Image size 2352x1568:
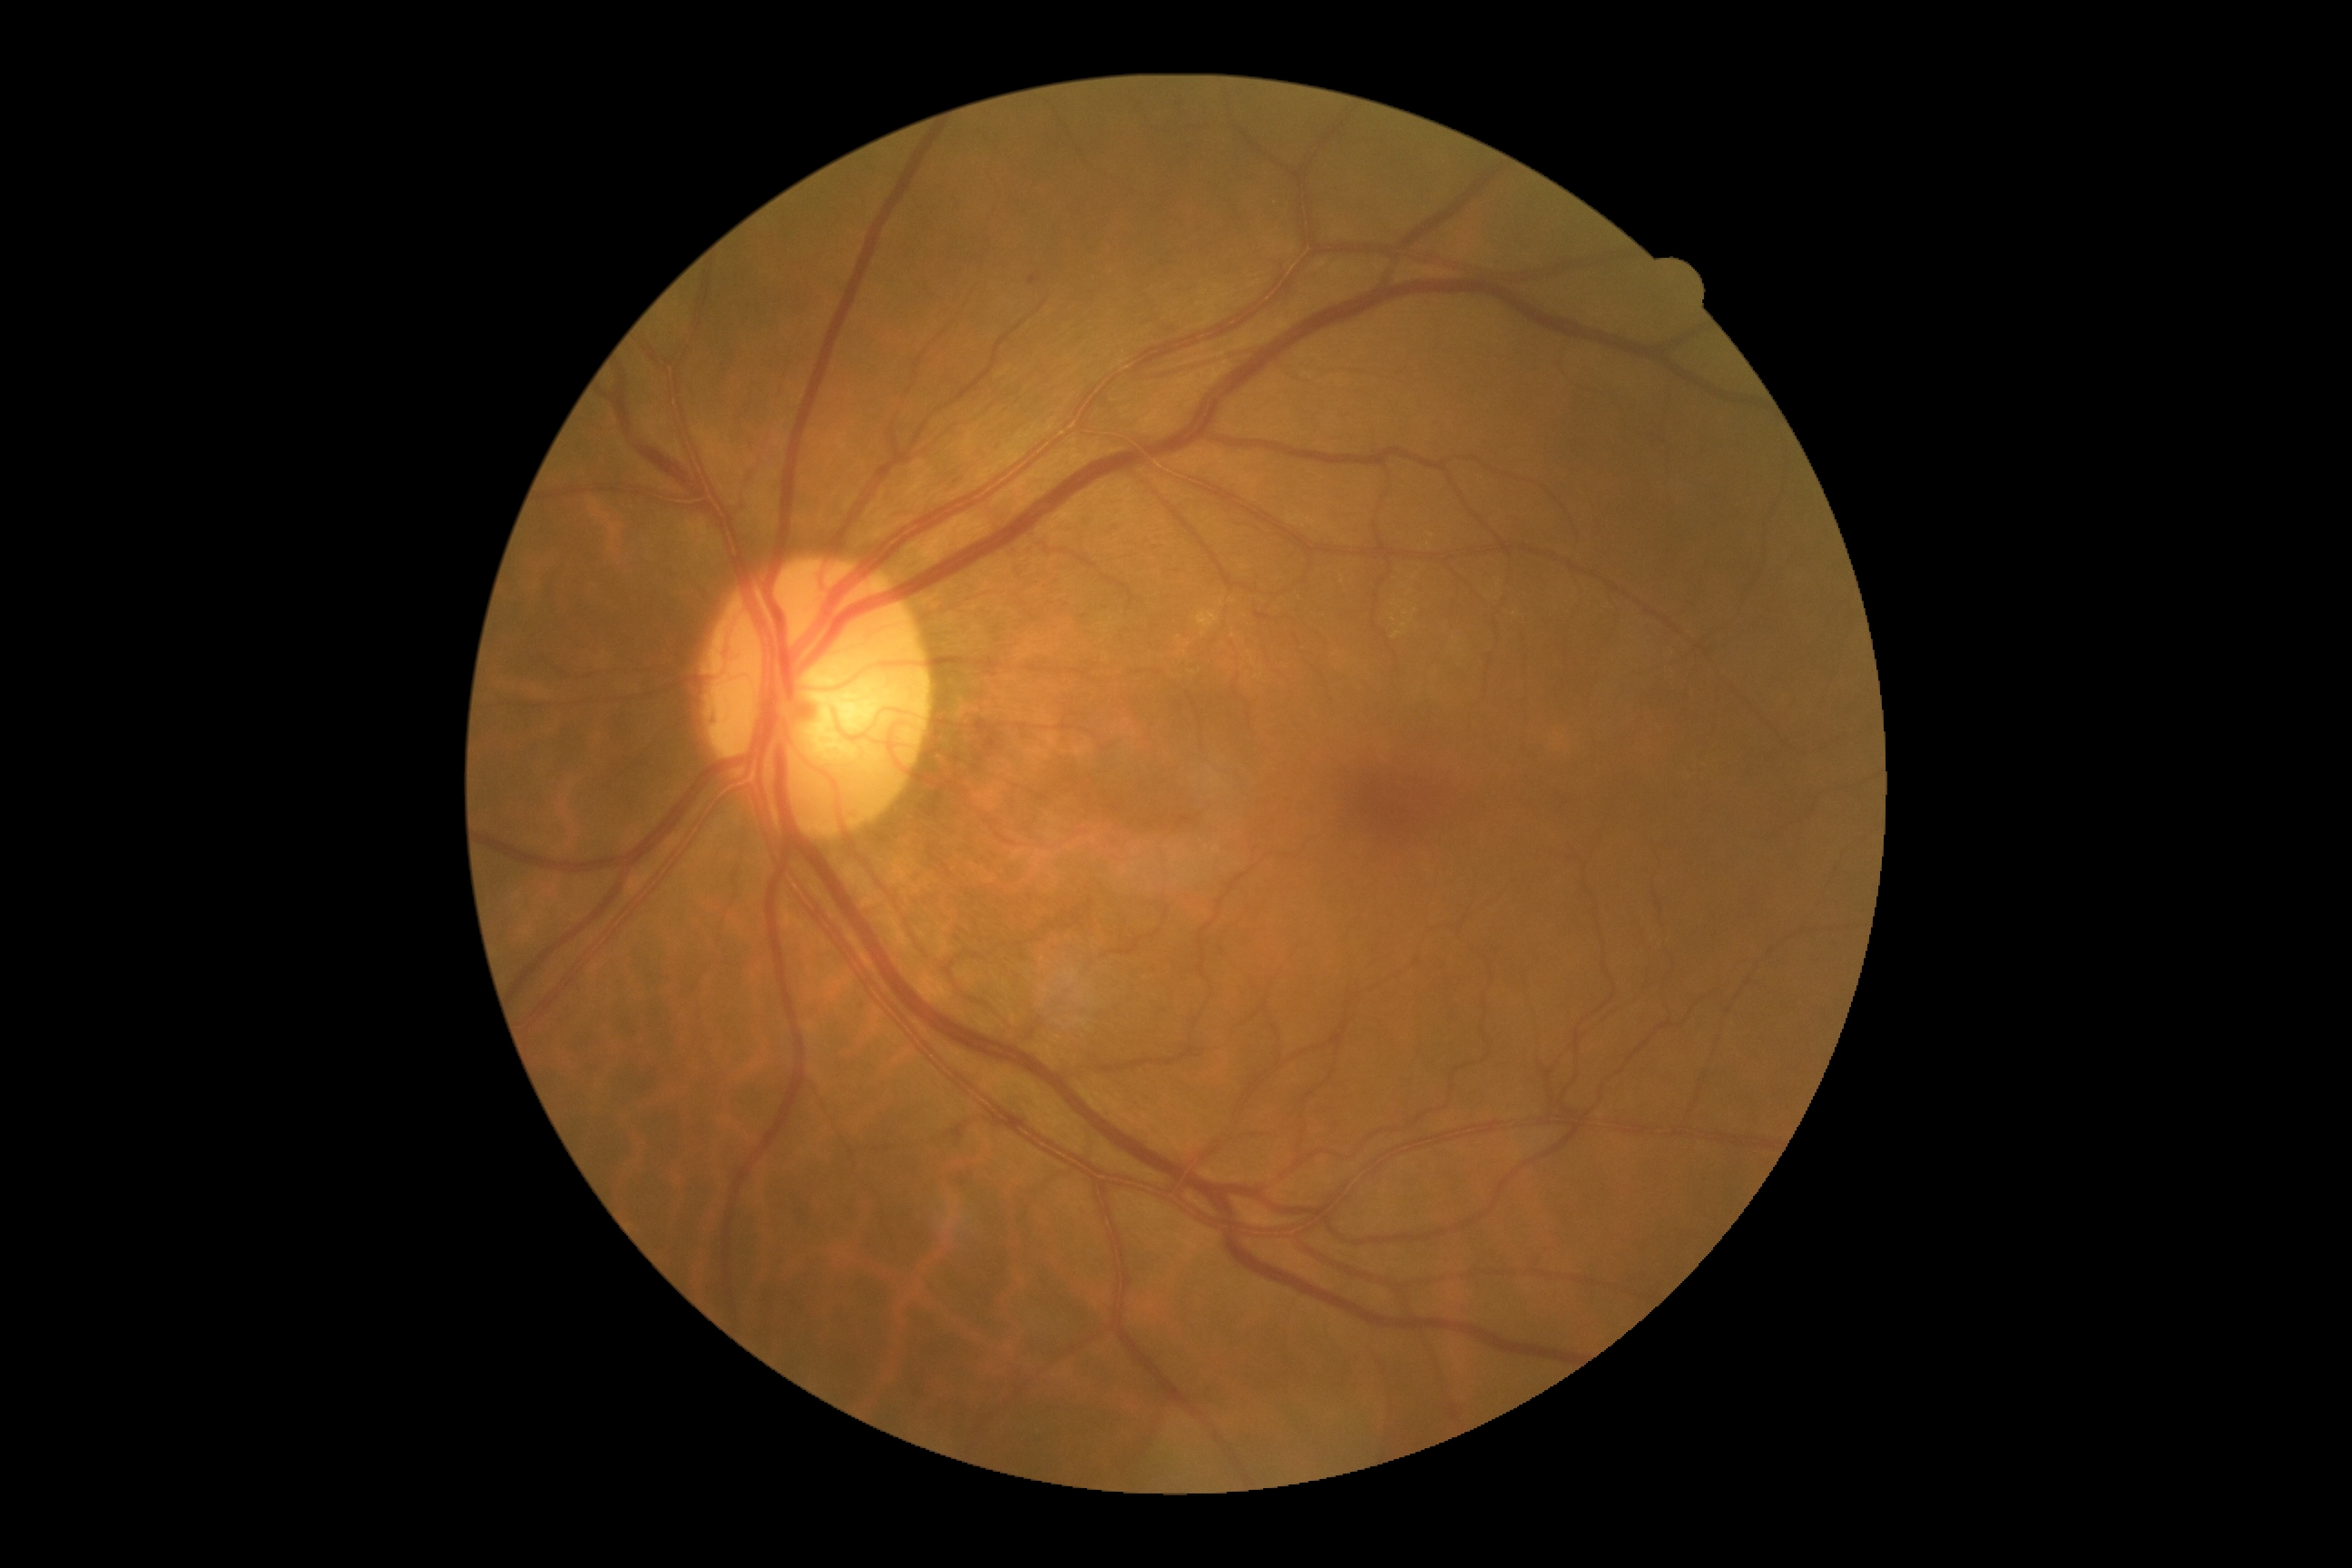

DR stage: grade 2 (moderate NPDR) — more than just microaneurysms but less than severe NPDR.